45-degree field of view · color fundus photograph.
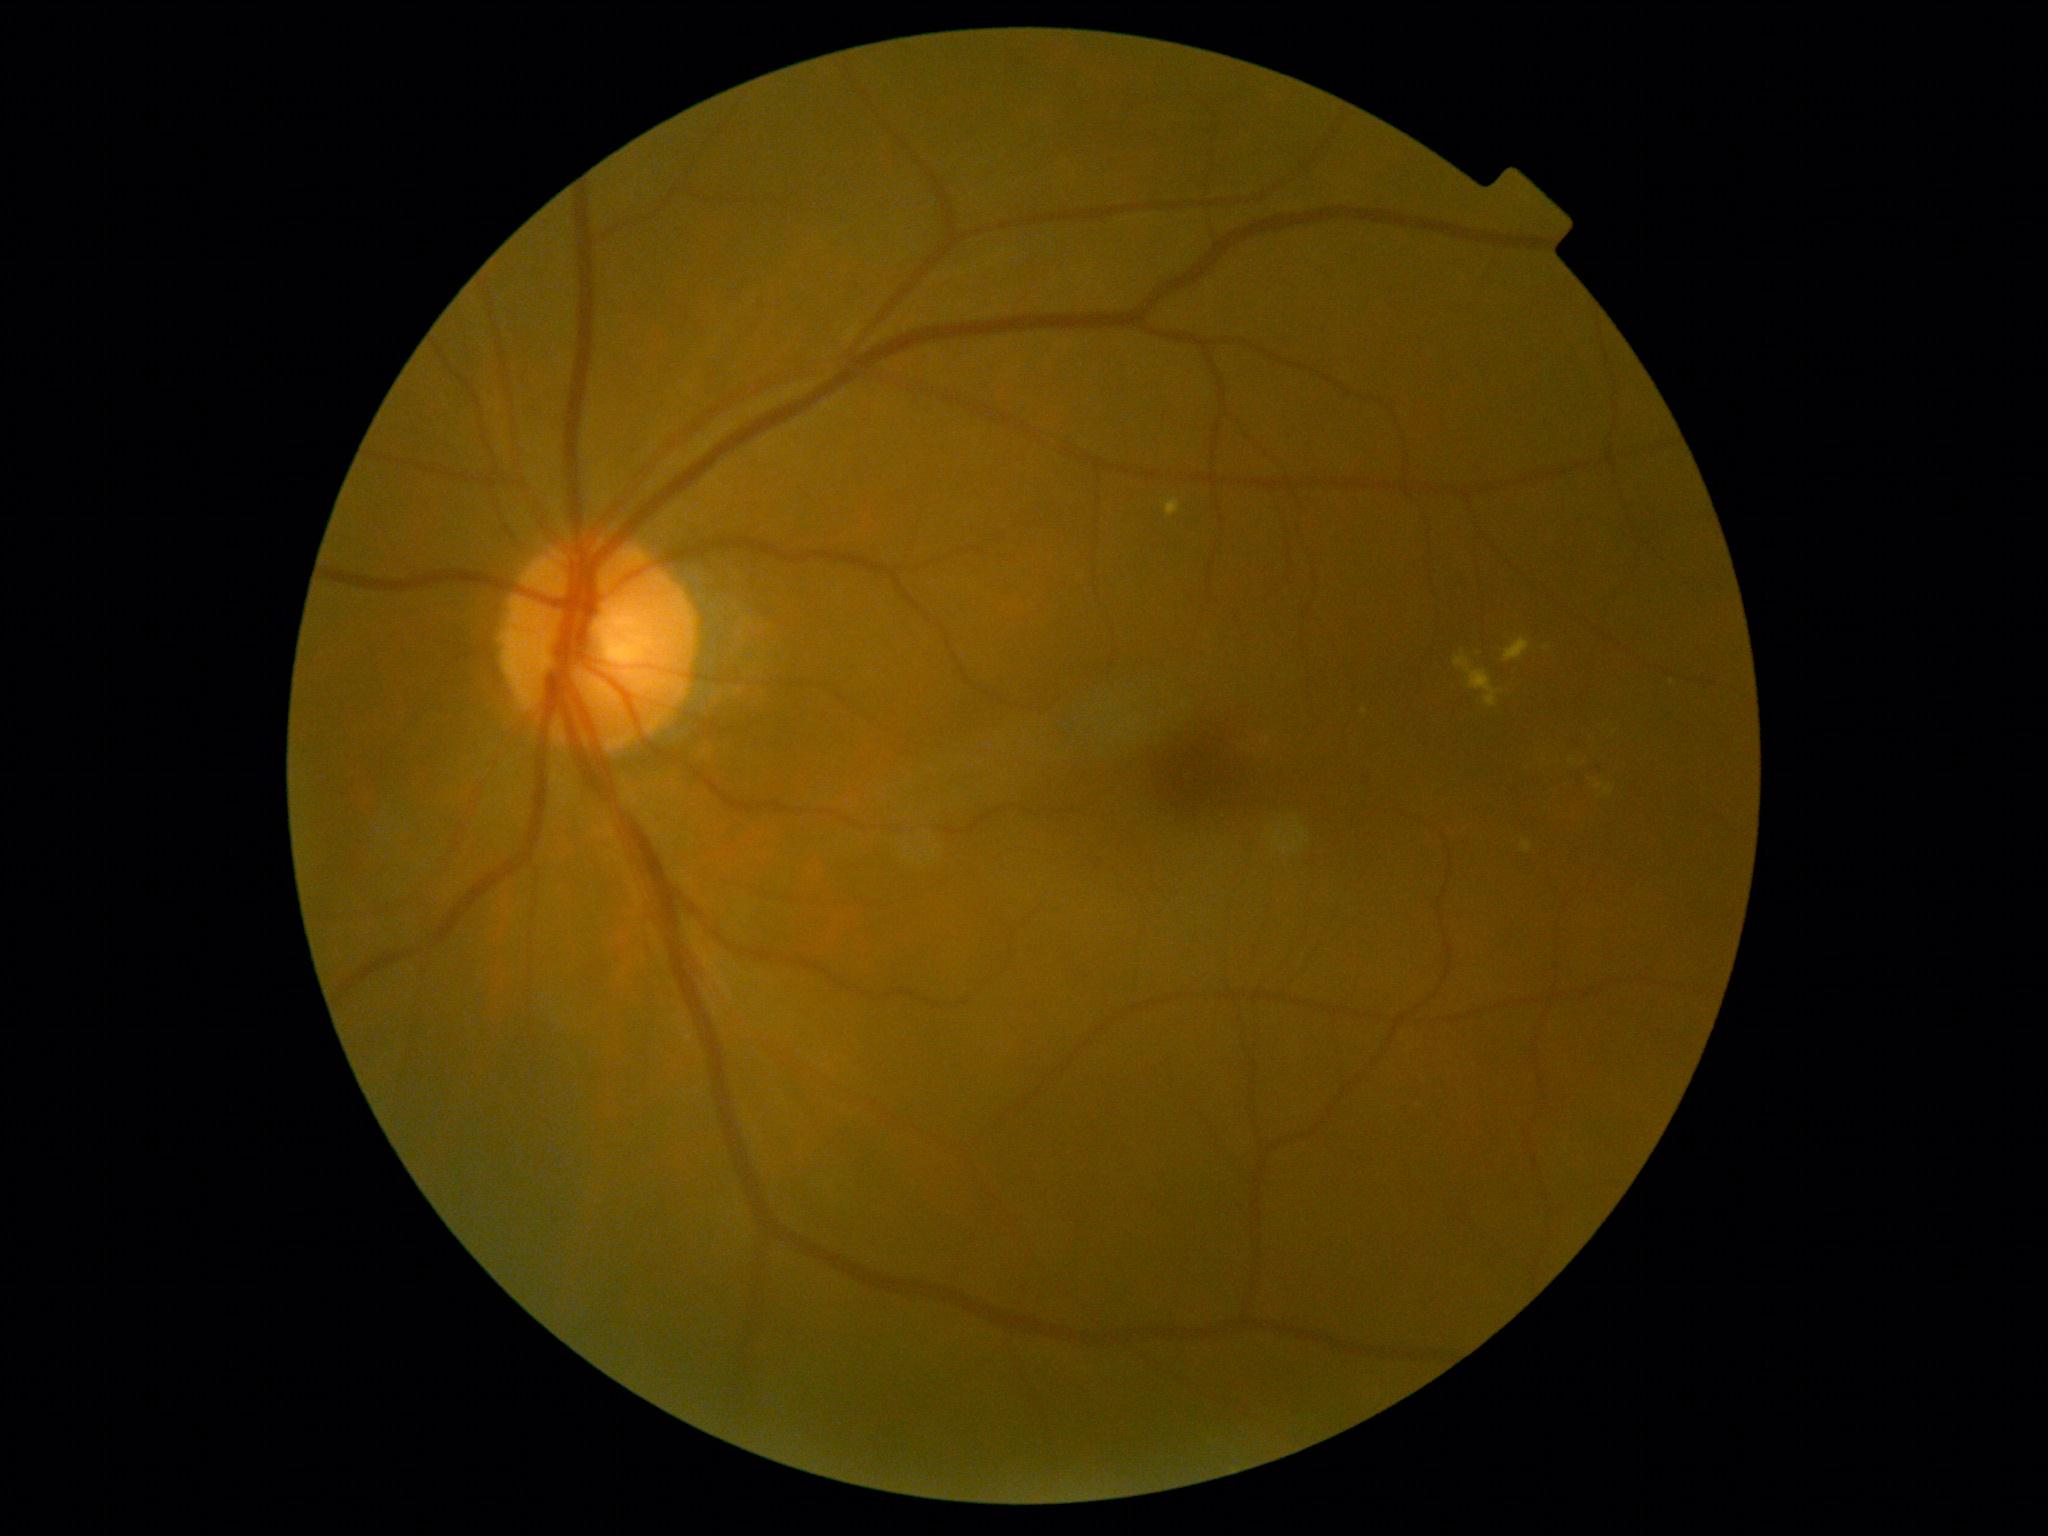
{"partial": true, "dr_grade": 2, "lesions": {"se": null, "ex": [[1595, 781, 1604, 790], [1165, 498, 1181, 517], [1504, 637, 1530, 663], [1604, 786, 1614, 796], [1522, 840, 1532, 853], [1454, 657, 1504, 708]], "ex_small": [[1572, 762], [1672, 682], [1547, 648], [1600, 798]], "ma": [[1366, 773, 1373, 788]], "he": null}}